Image size 2212x1659.
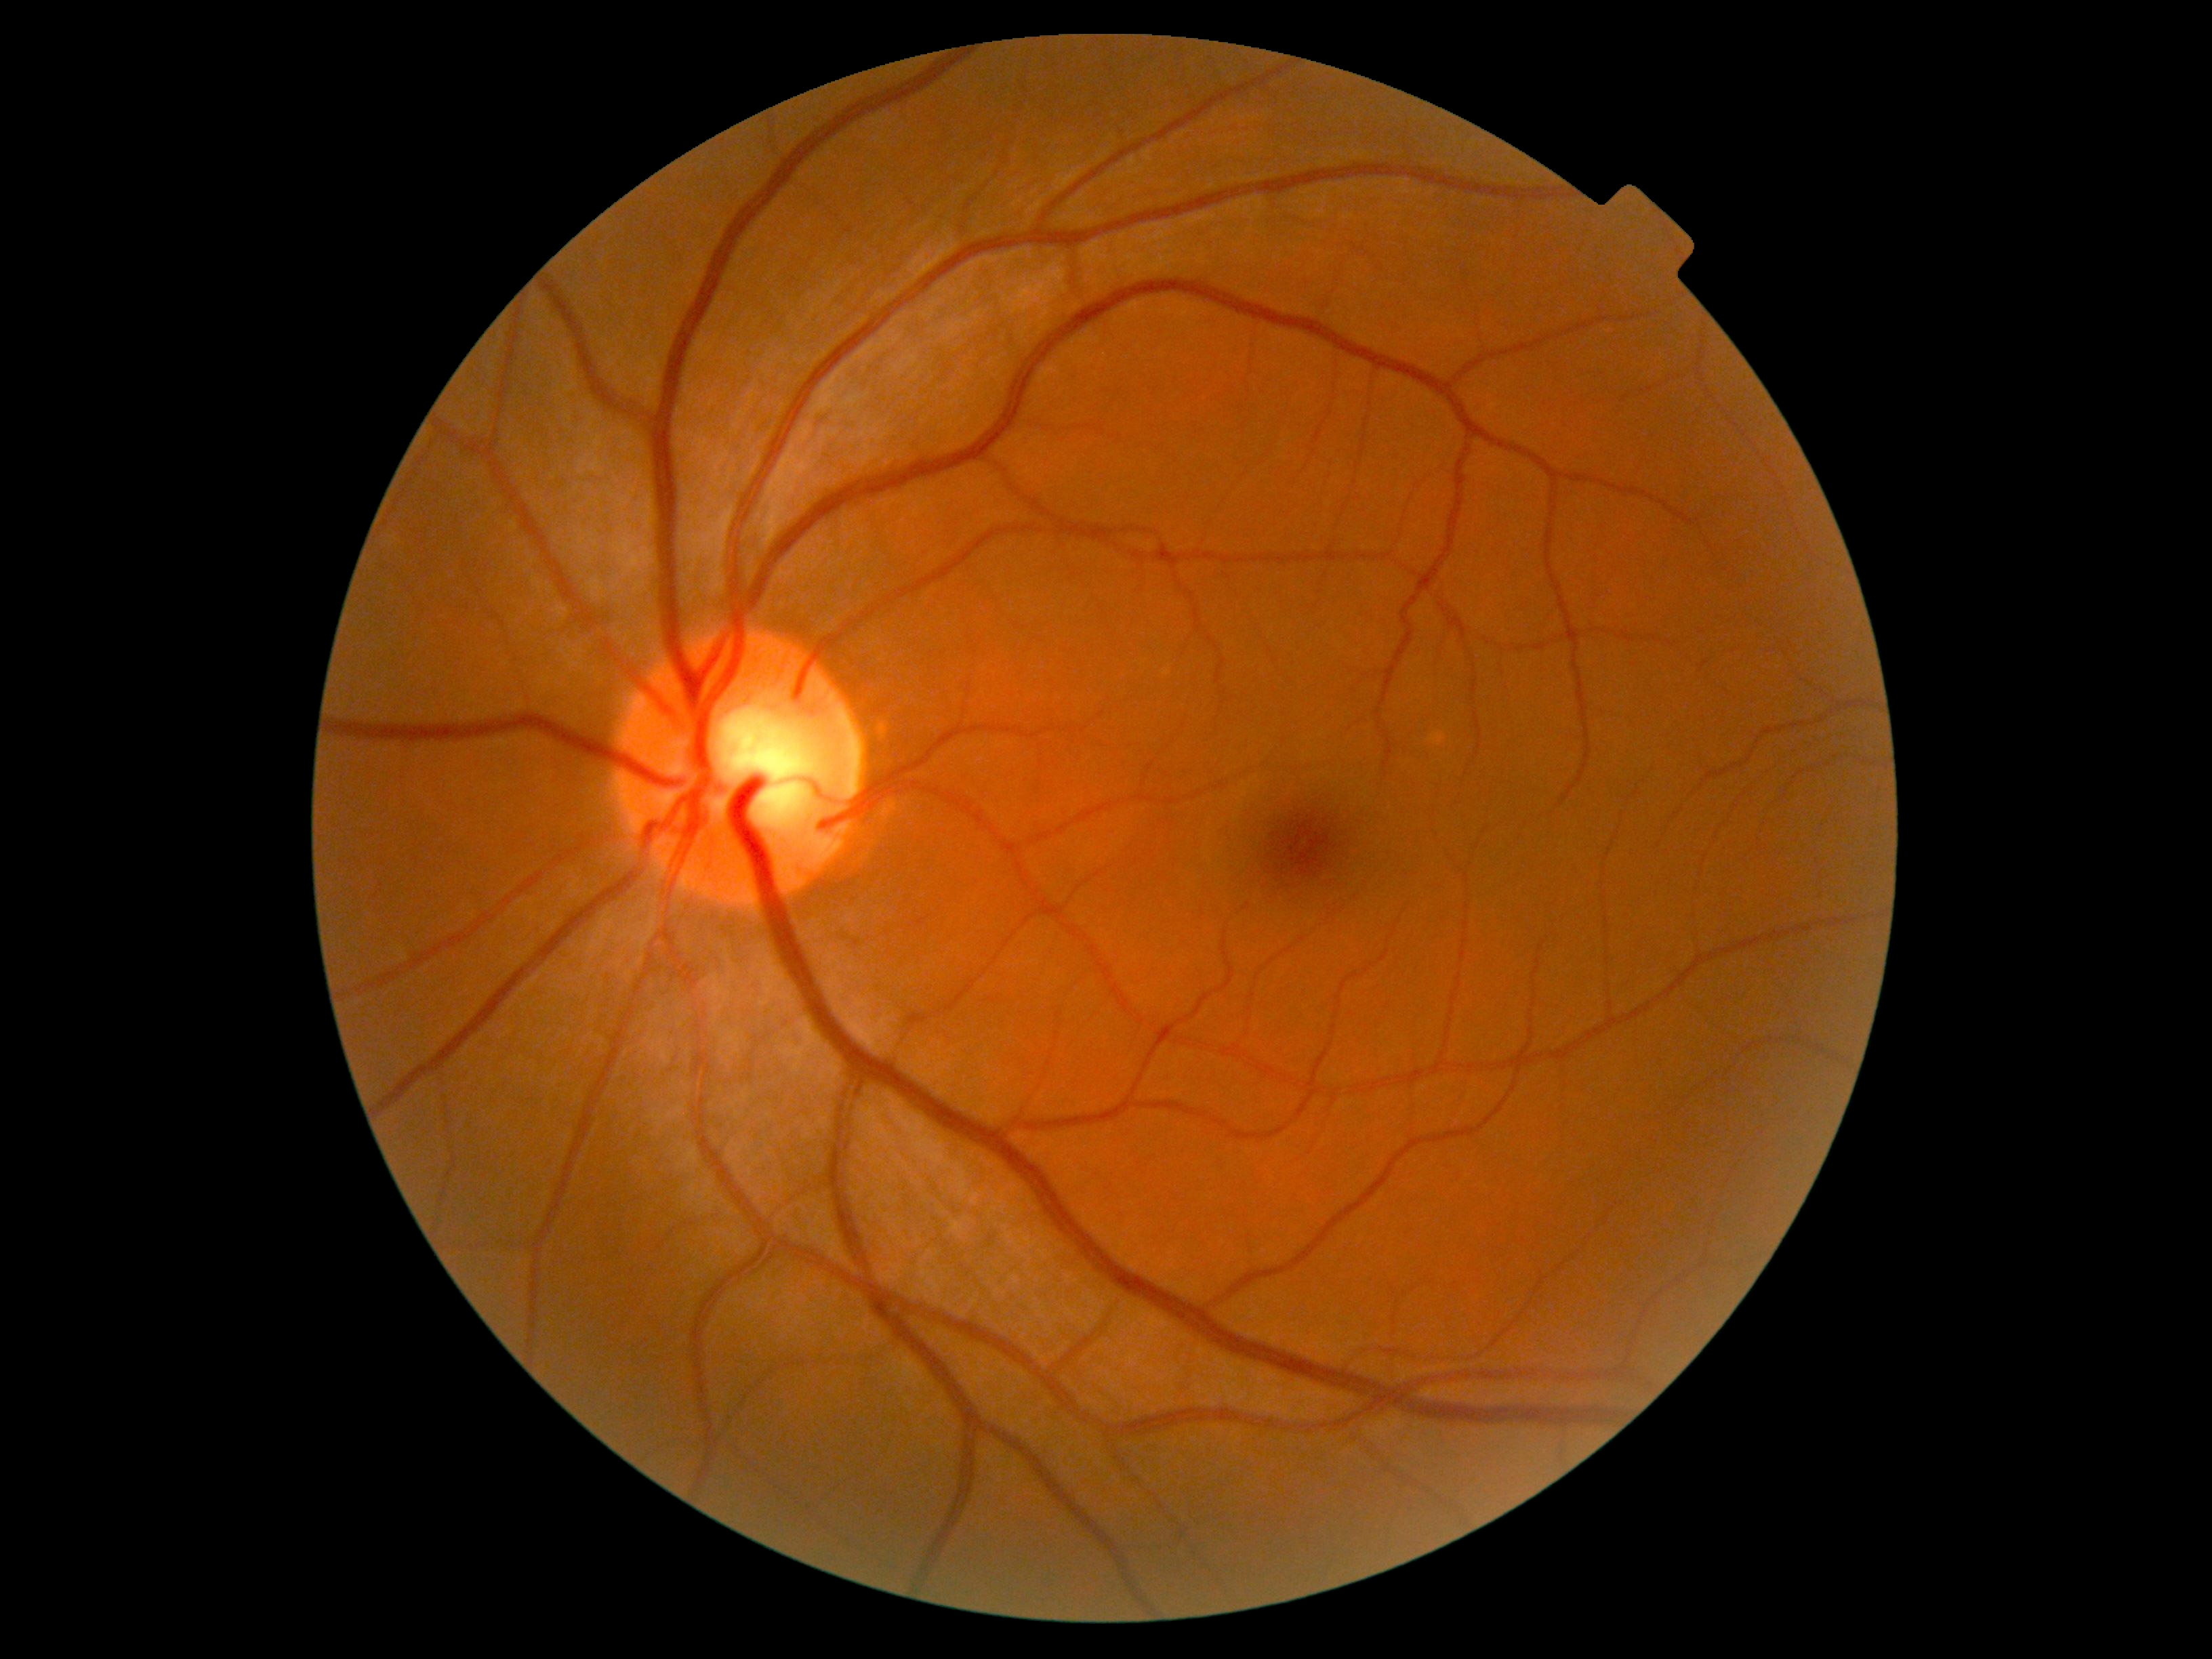
DR severity is no apparent retinopathy (grade 0).